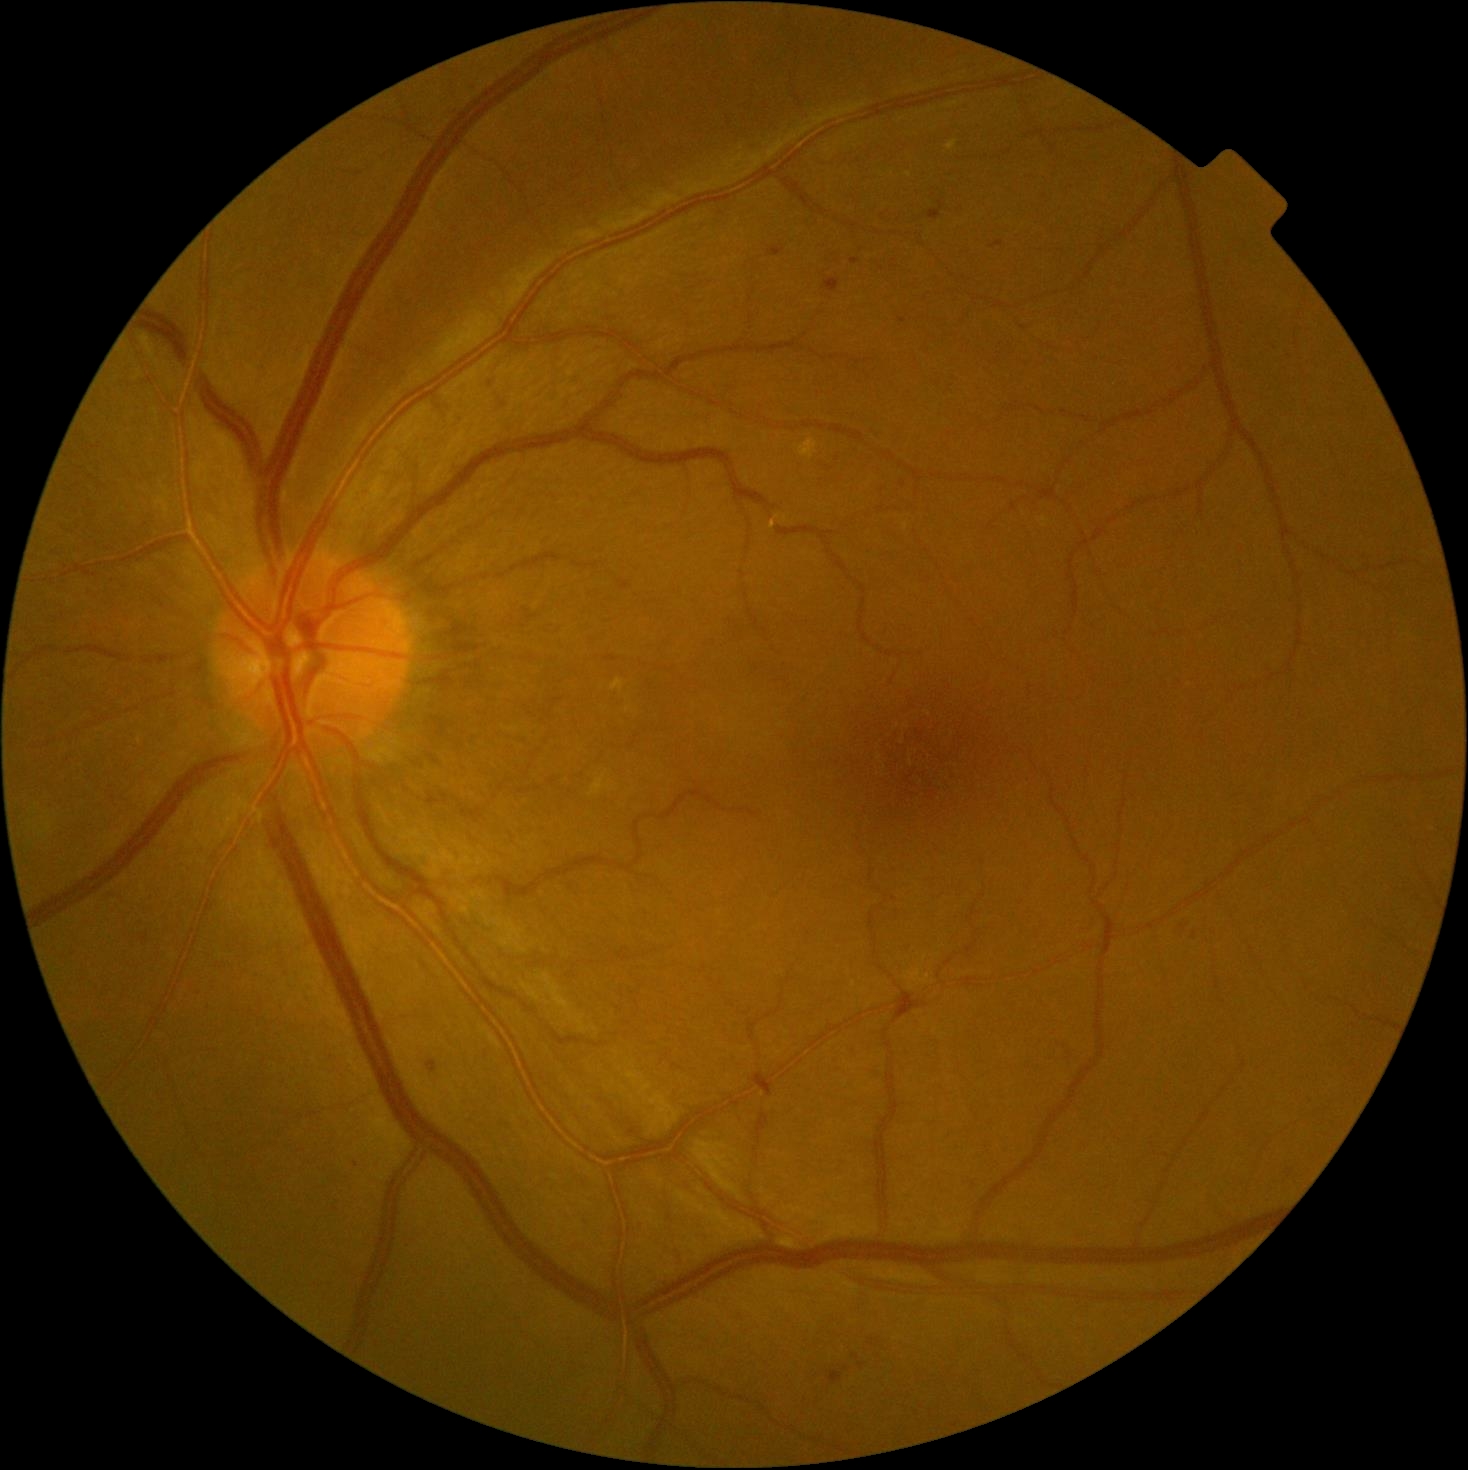 Diabetic retinopathy is grade 2 — more than just microaneurysms but less than severe NPDR.